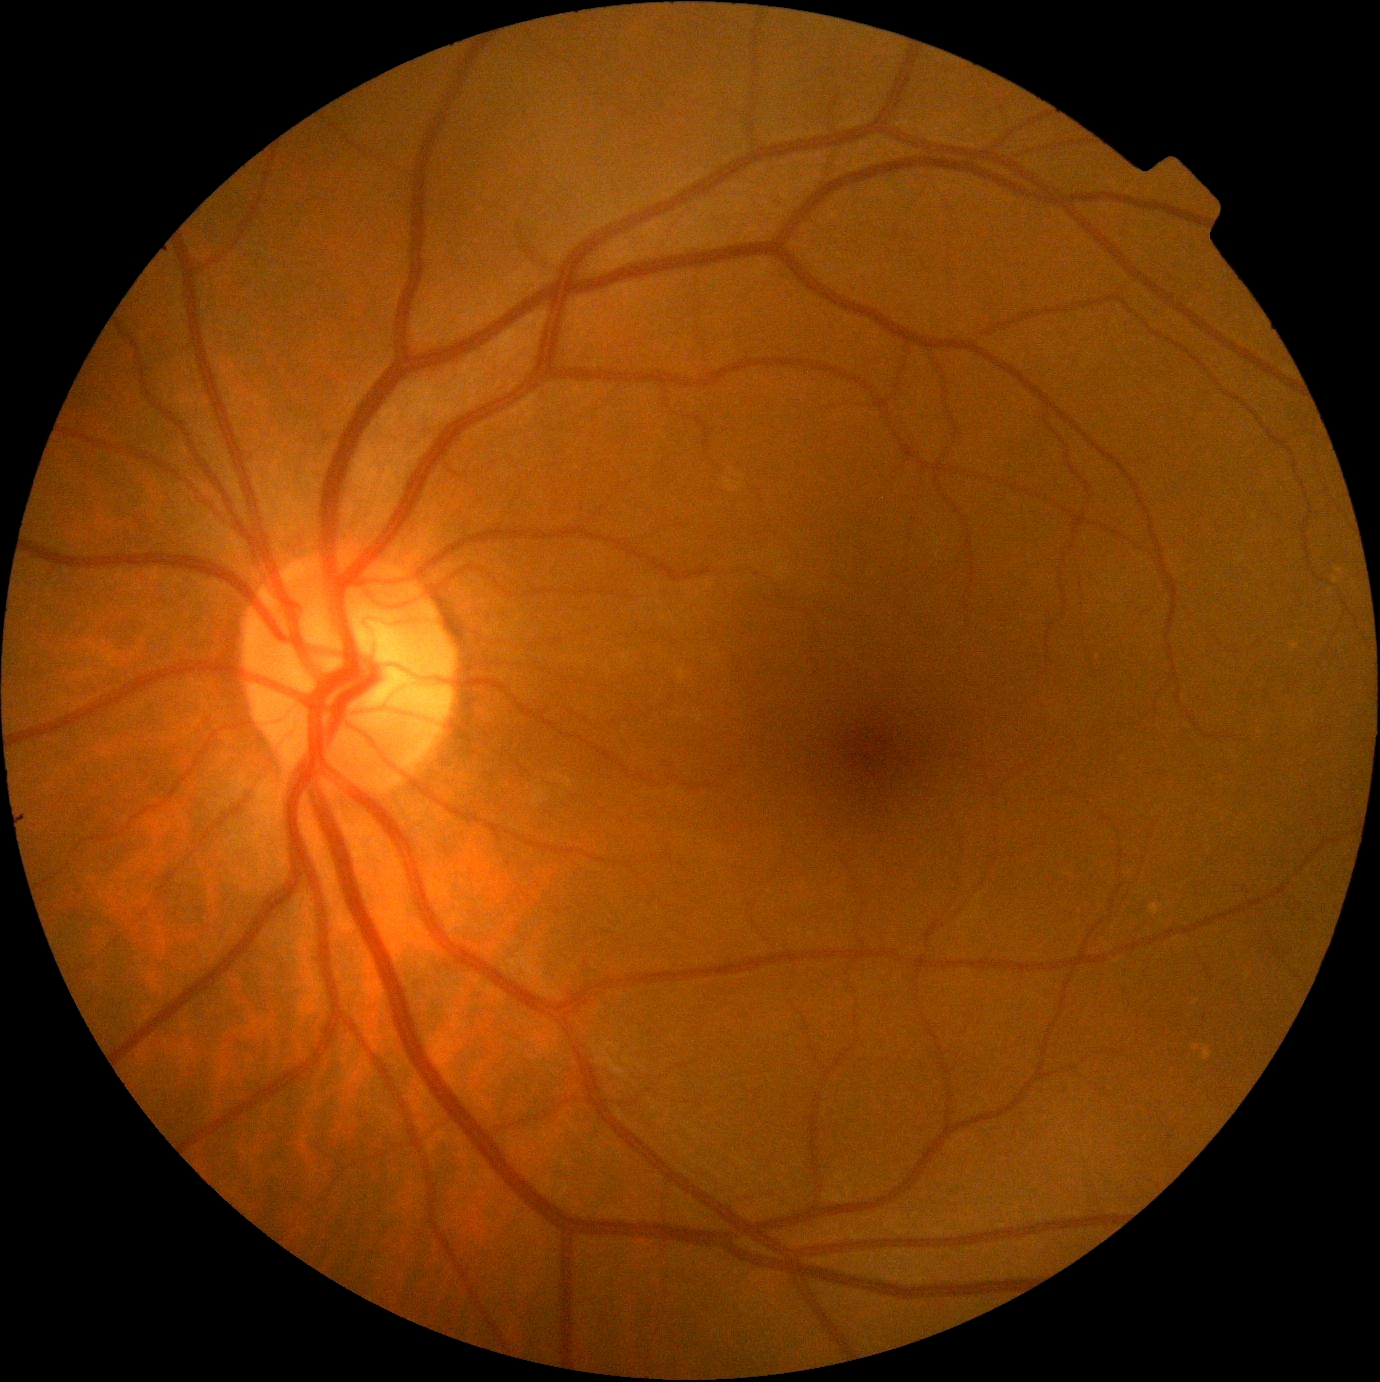
dr_grade: 0/4